Wide-field retinal mosaic image — 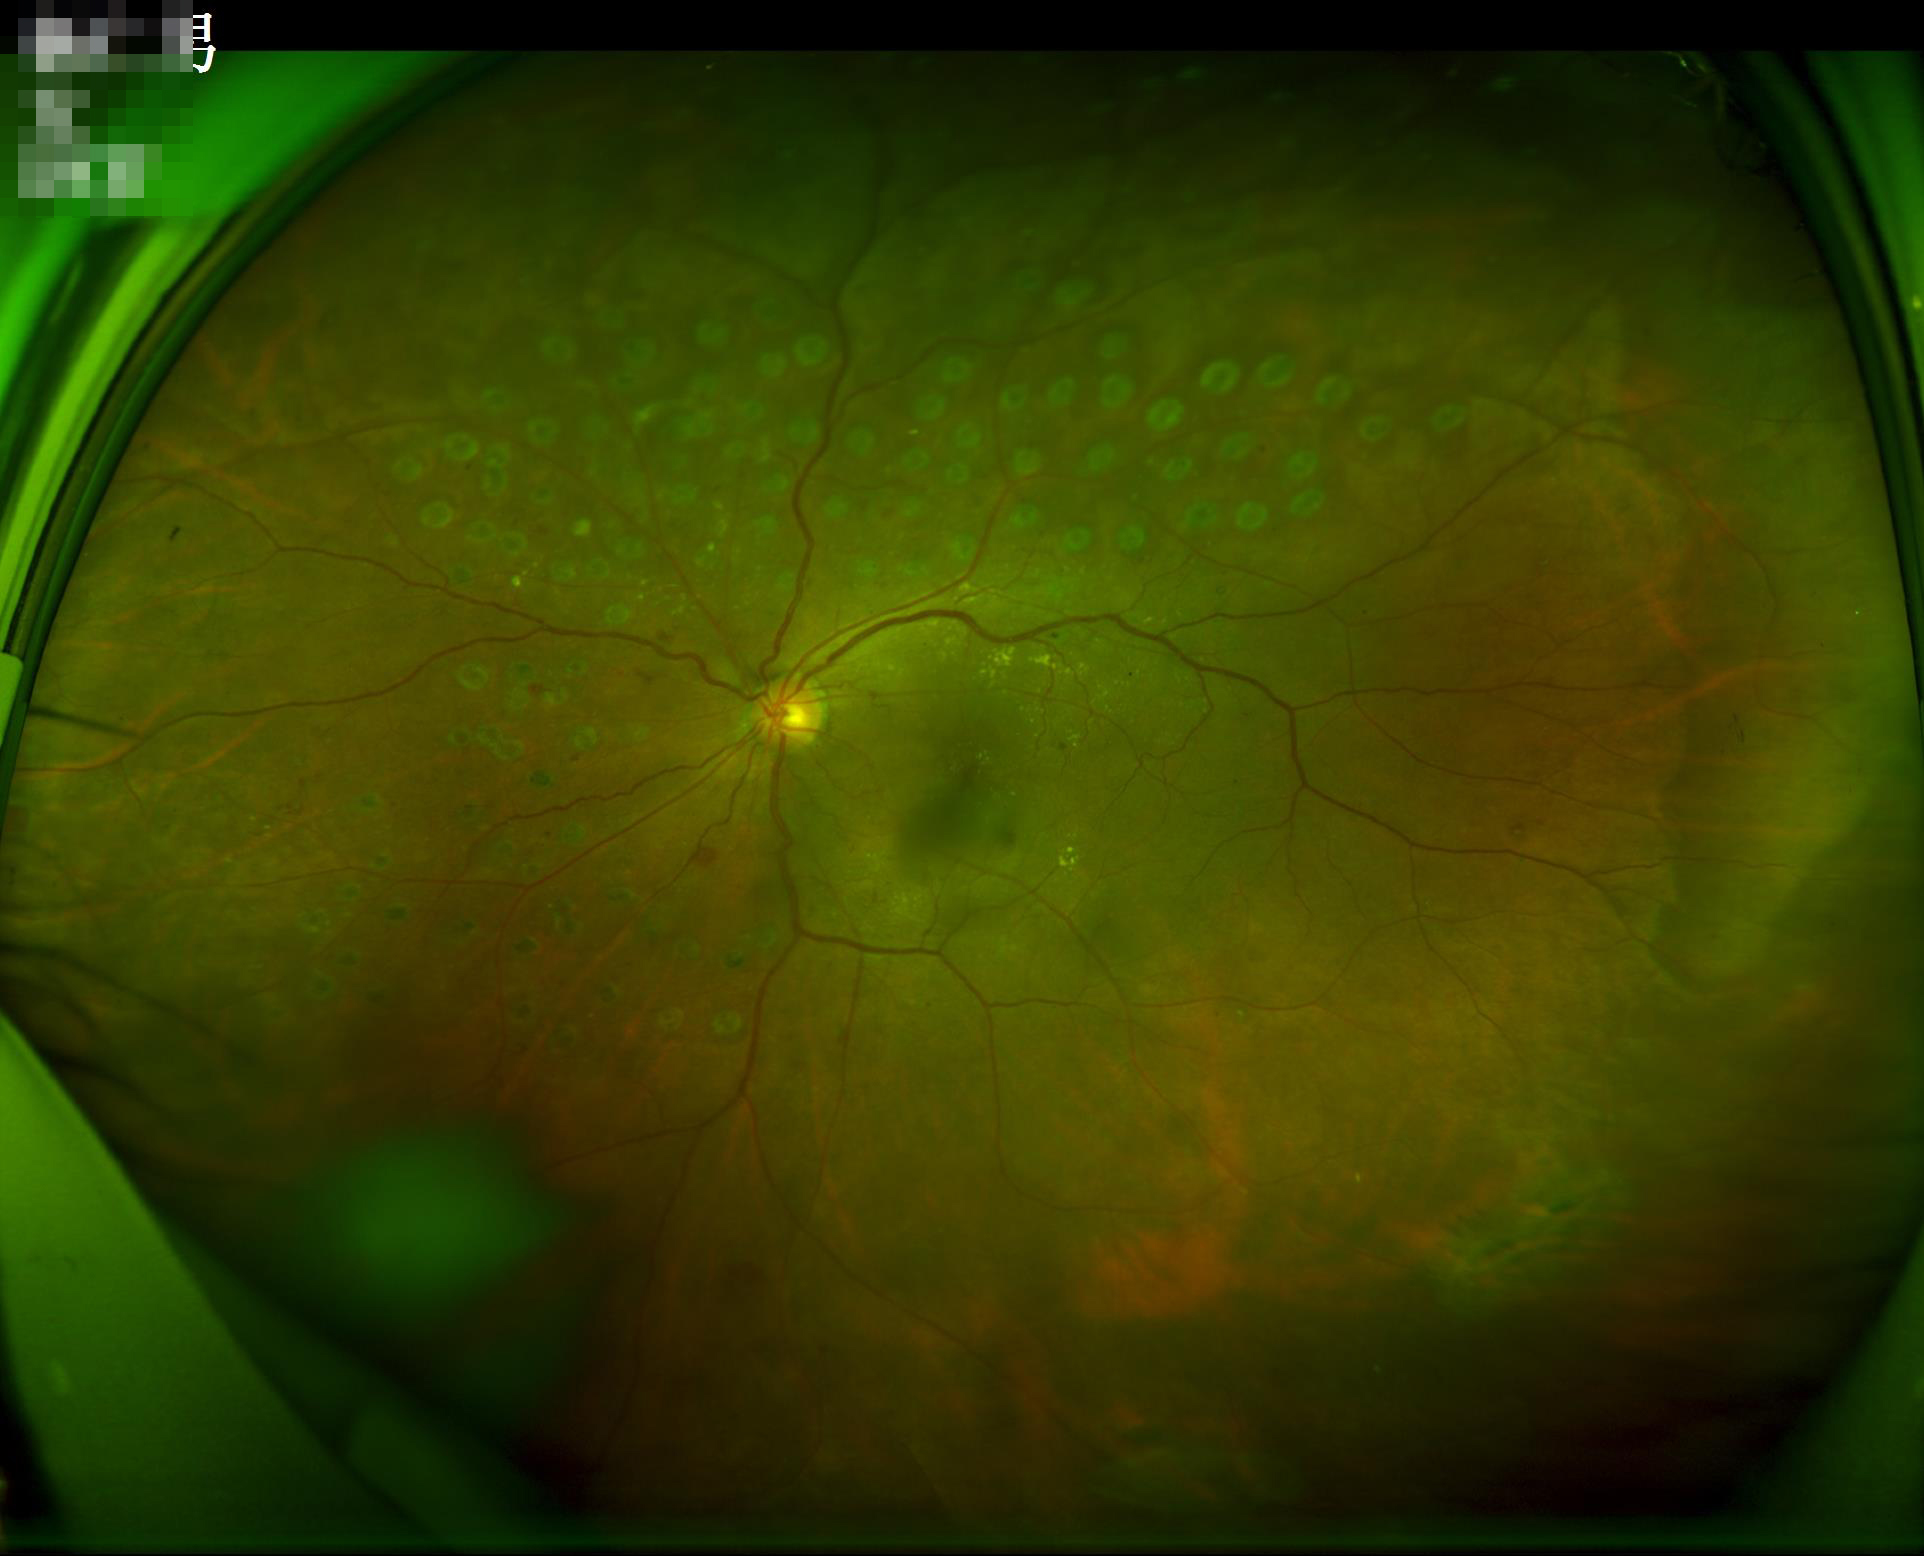
Optic disc, vessels, and background are in focus.
Even illumination with no color cast.
Image quality is adequate for diagnostic use.